Infant wide-field retinal image
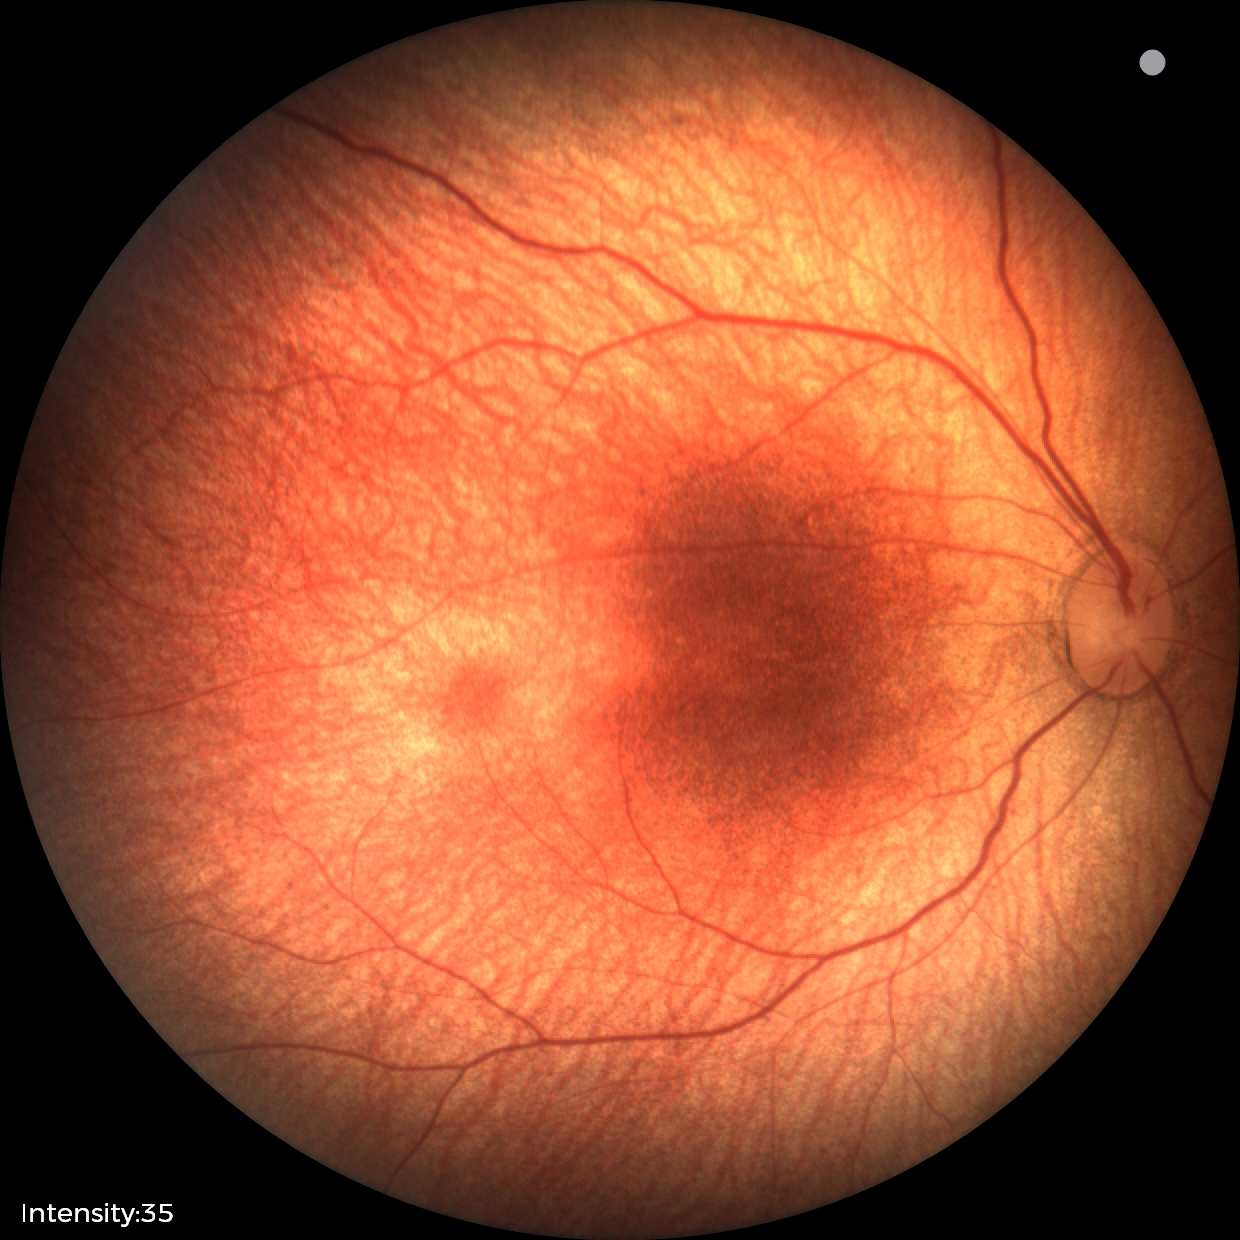 No retinal pathology identified on screening.